Acquired on the Phoenix ICON · 1240x1240 · pediatric wide-field fundus photograph: 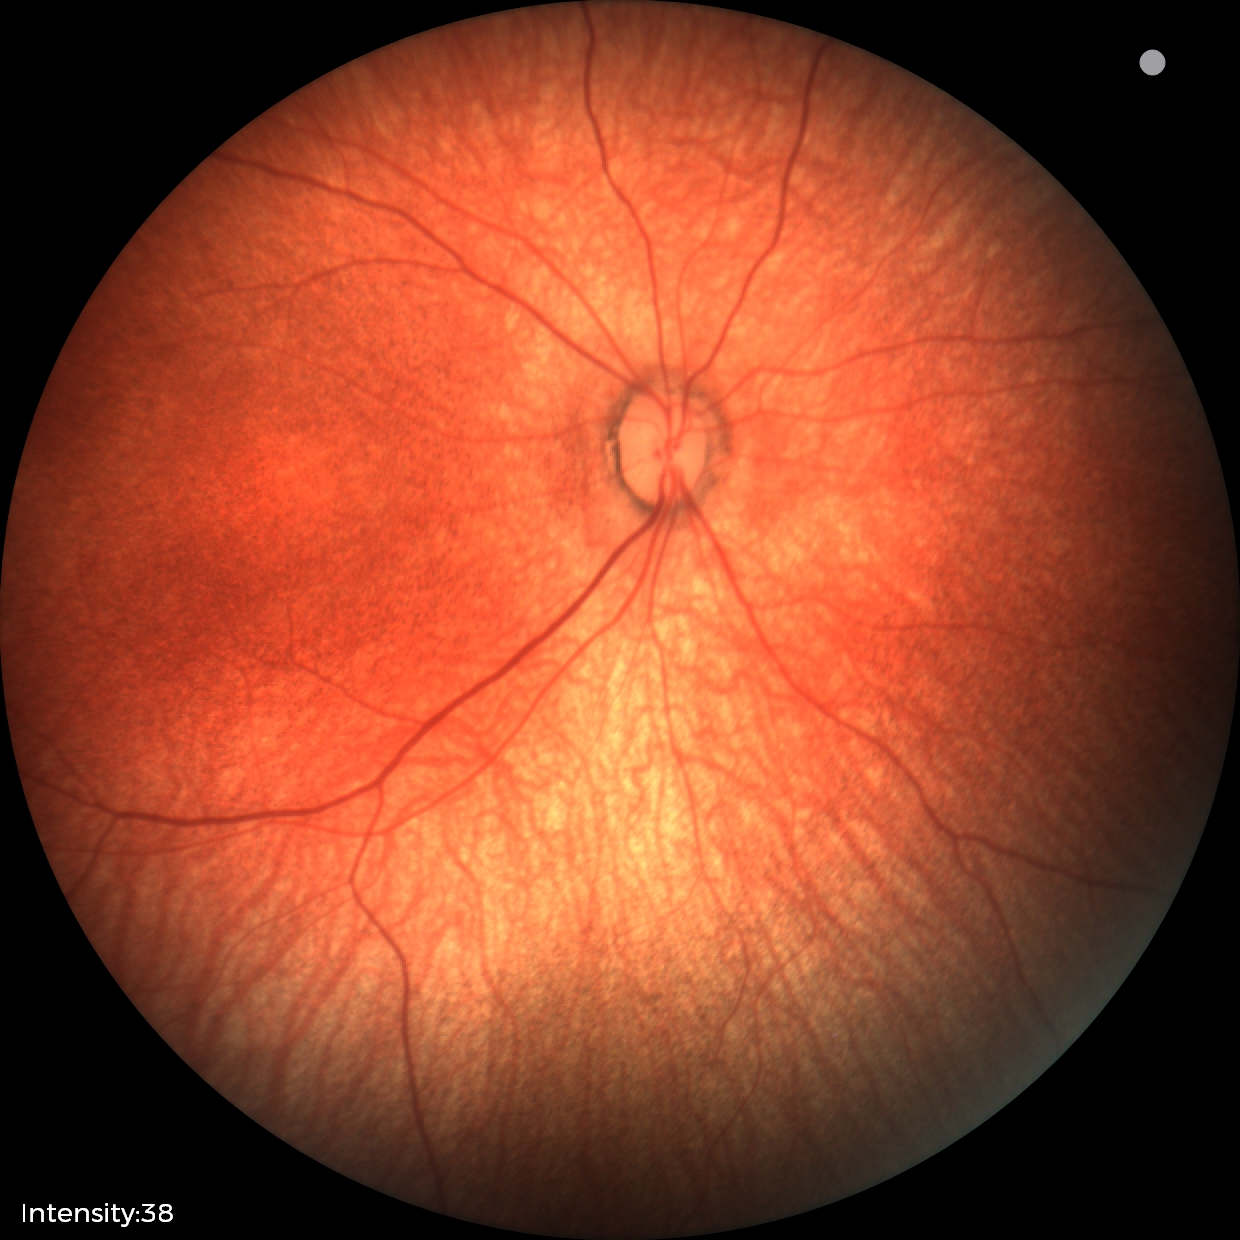

No retinal pathology identified on screening.